Retinal fundus photograph.
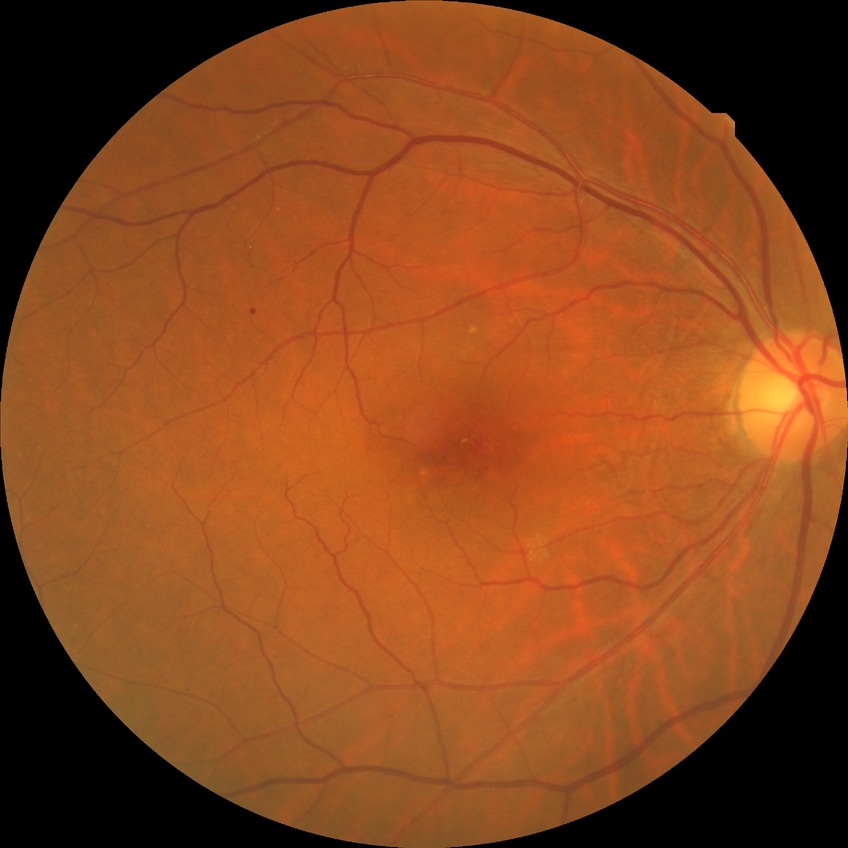
Diabetic retinopathy severity is simple diabetic retinopathy.